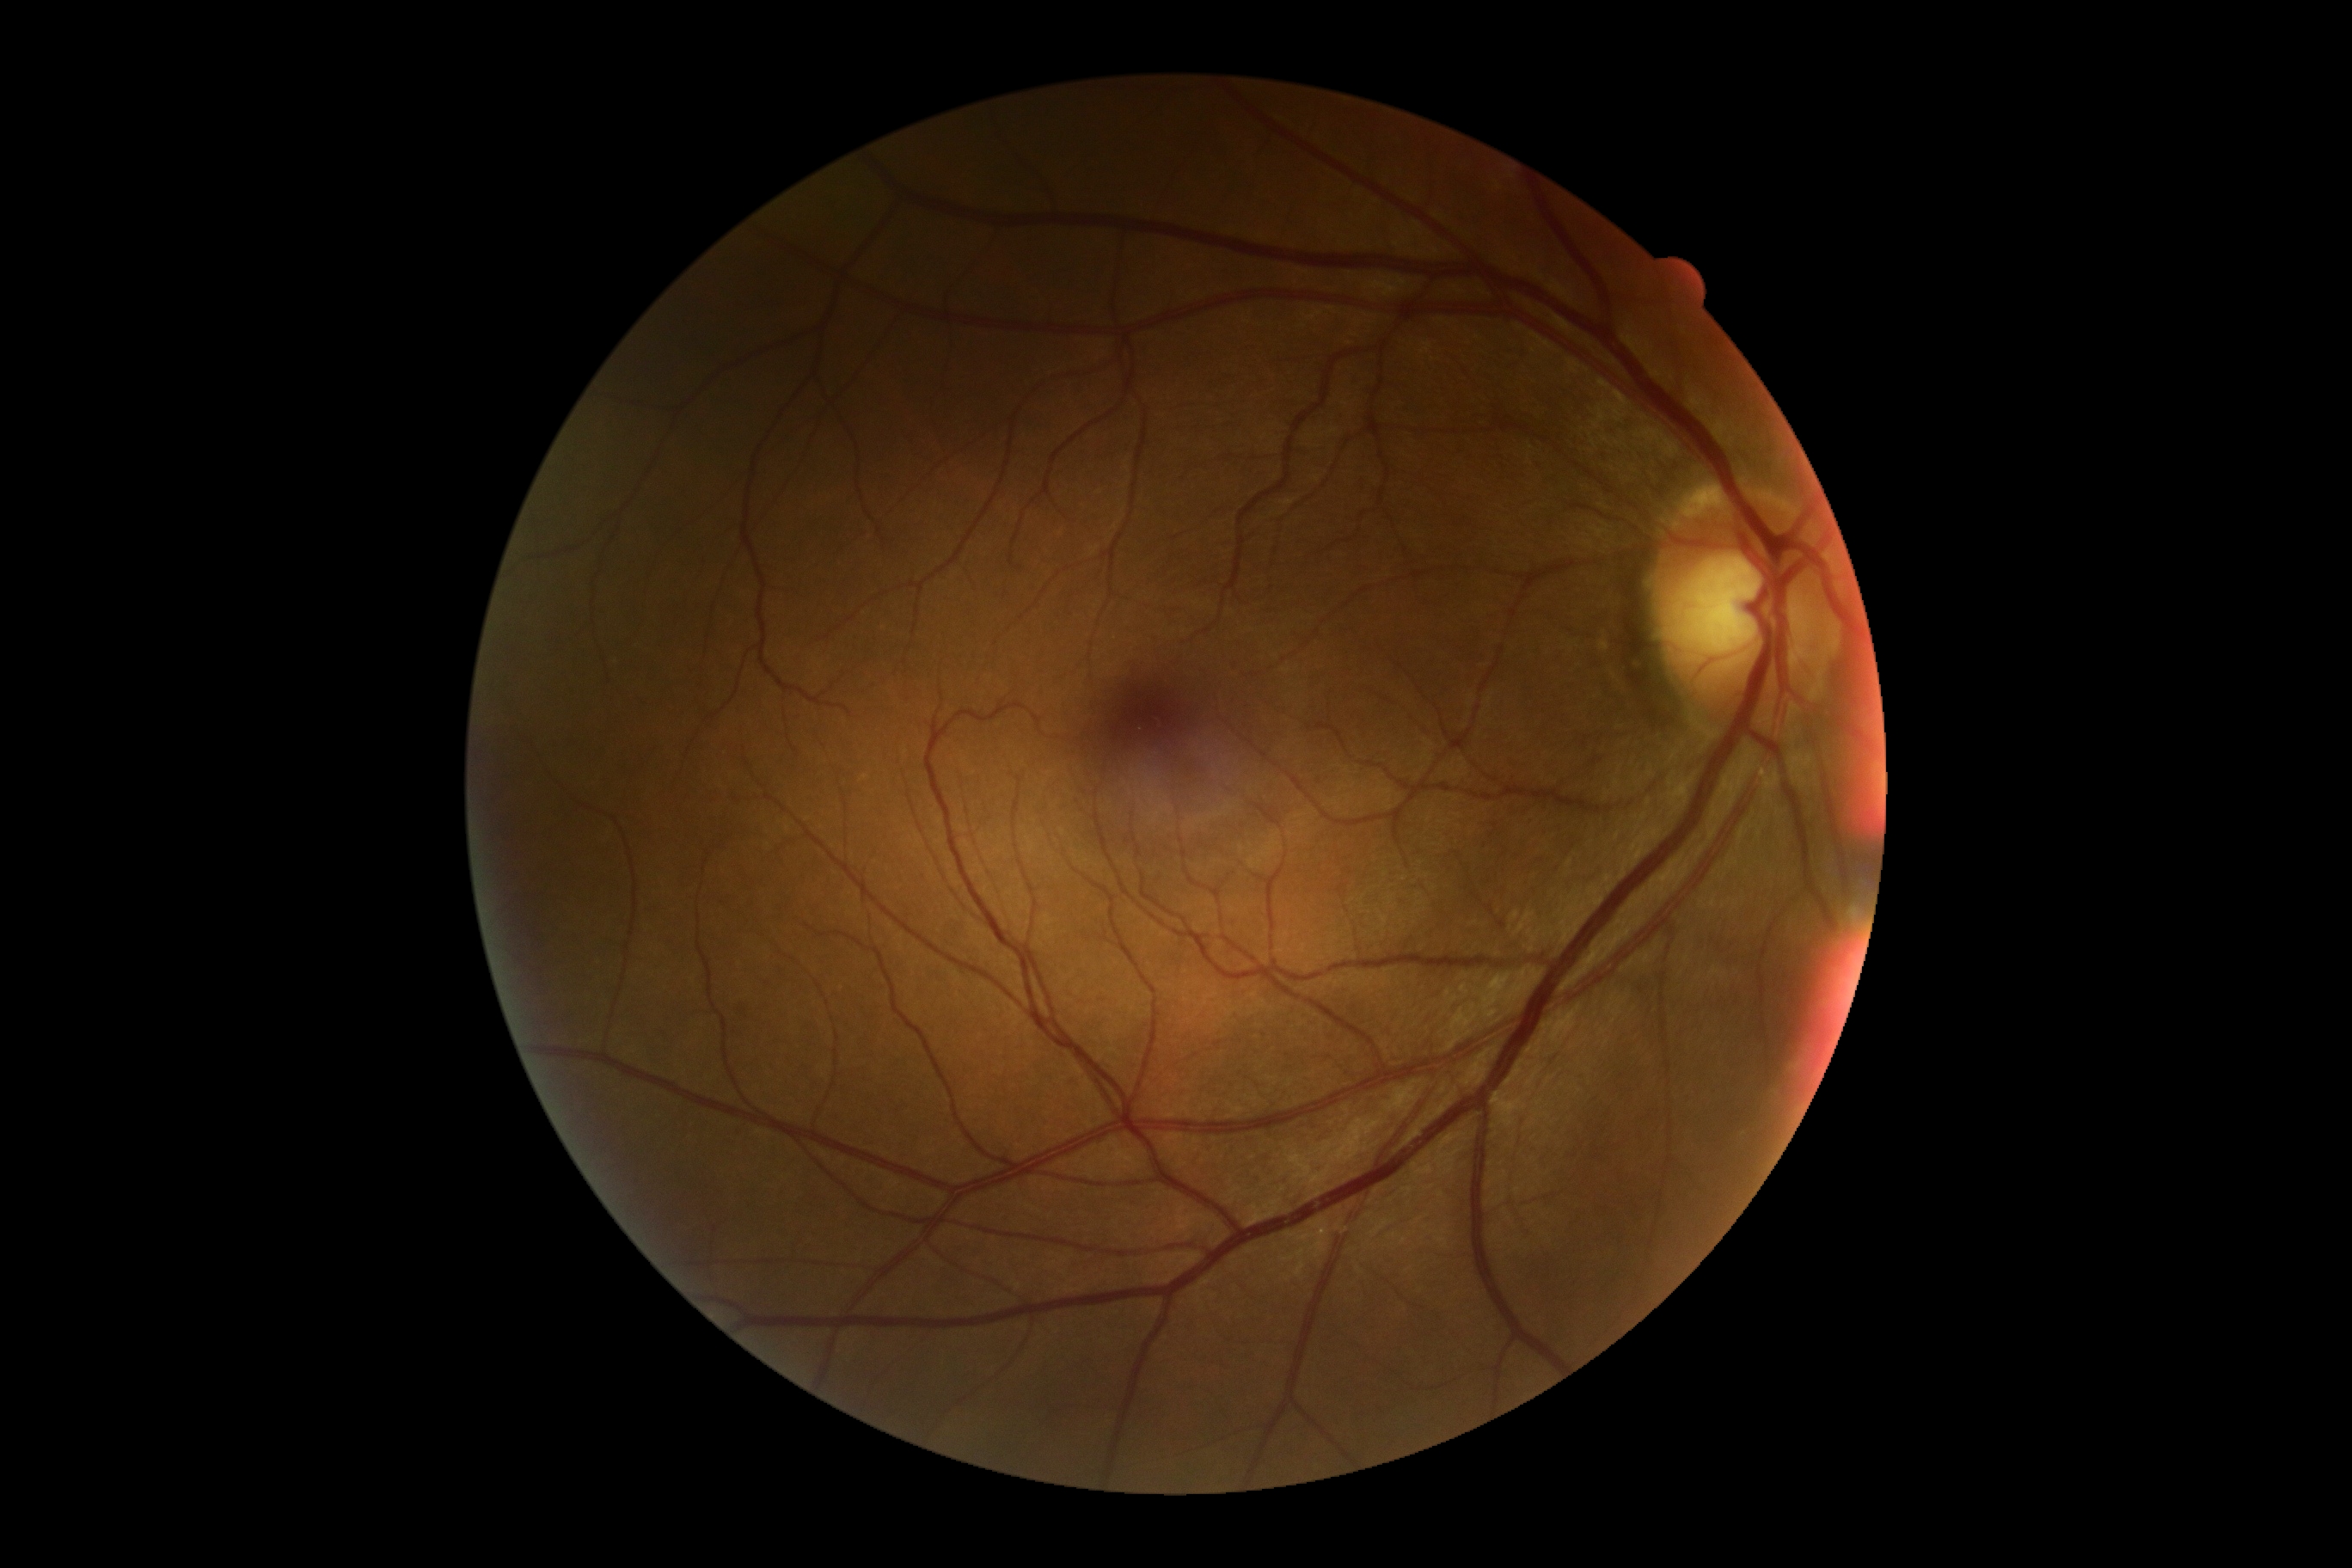 Diabetic retinopathy (DR): no apparent diabetic retinopathy (grade 0). No signs of diabetic retinopathy.